NIDEK AFC-230, 848x848px — 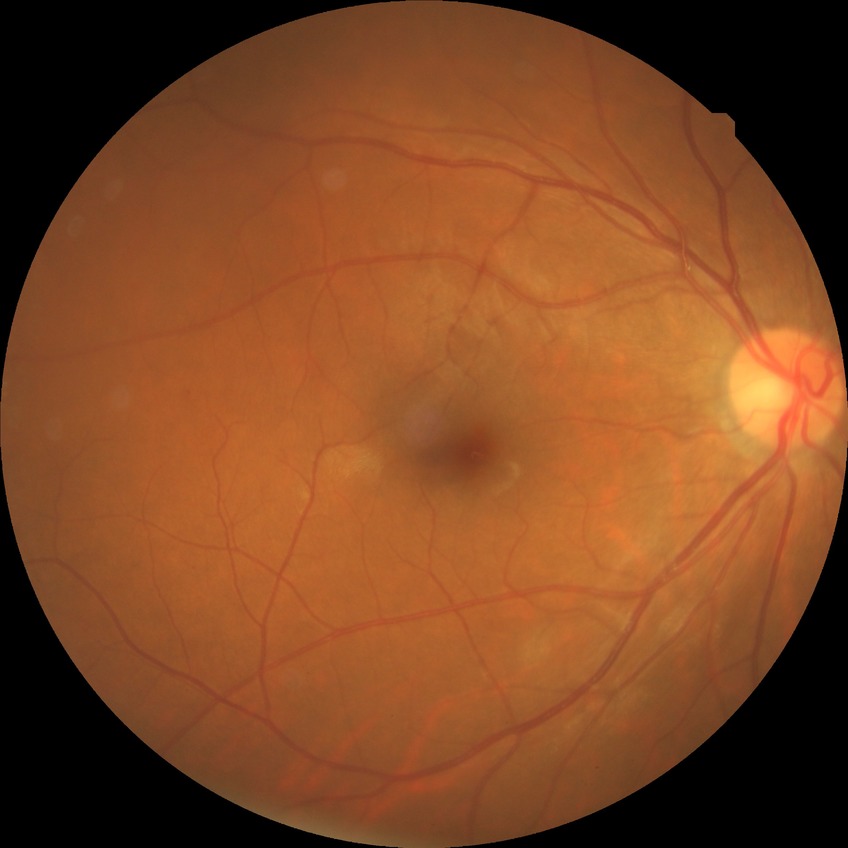
davis_grade: no diabetic retinopathy